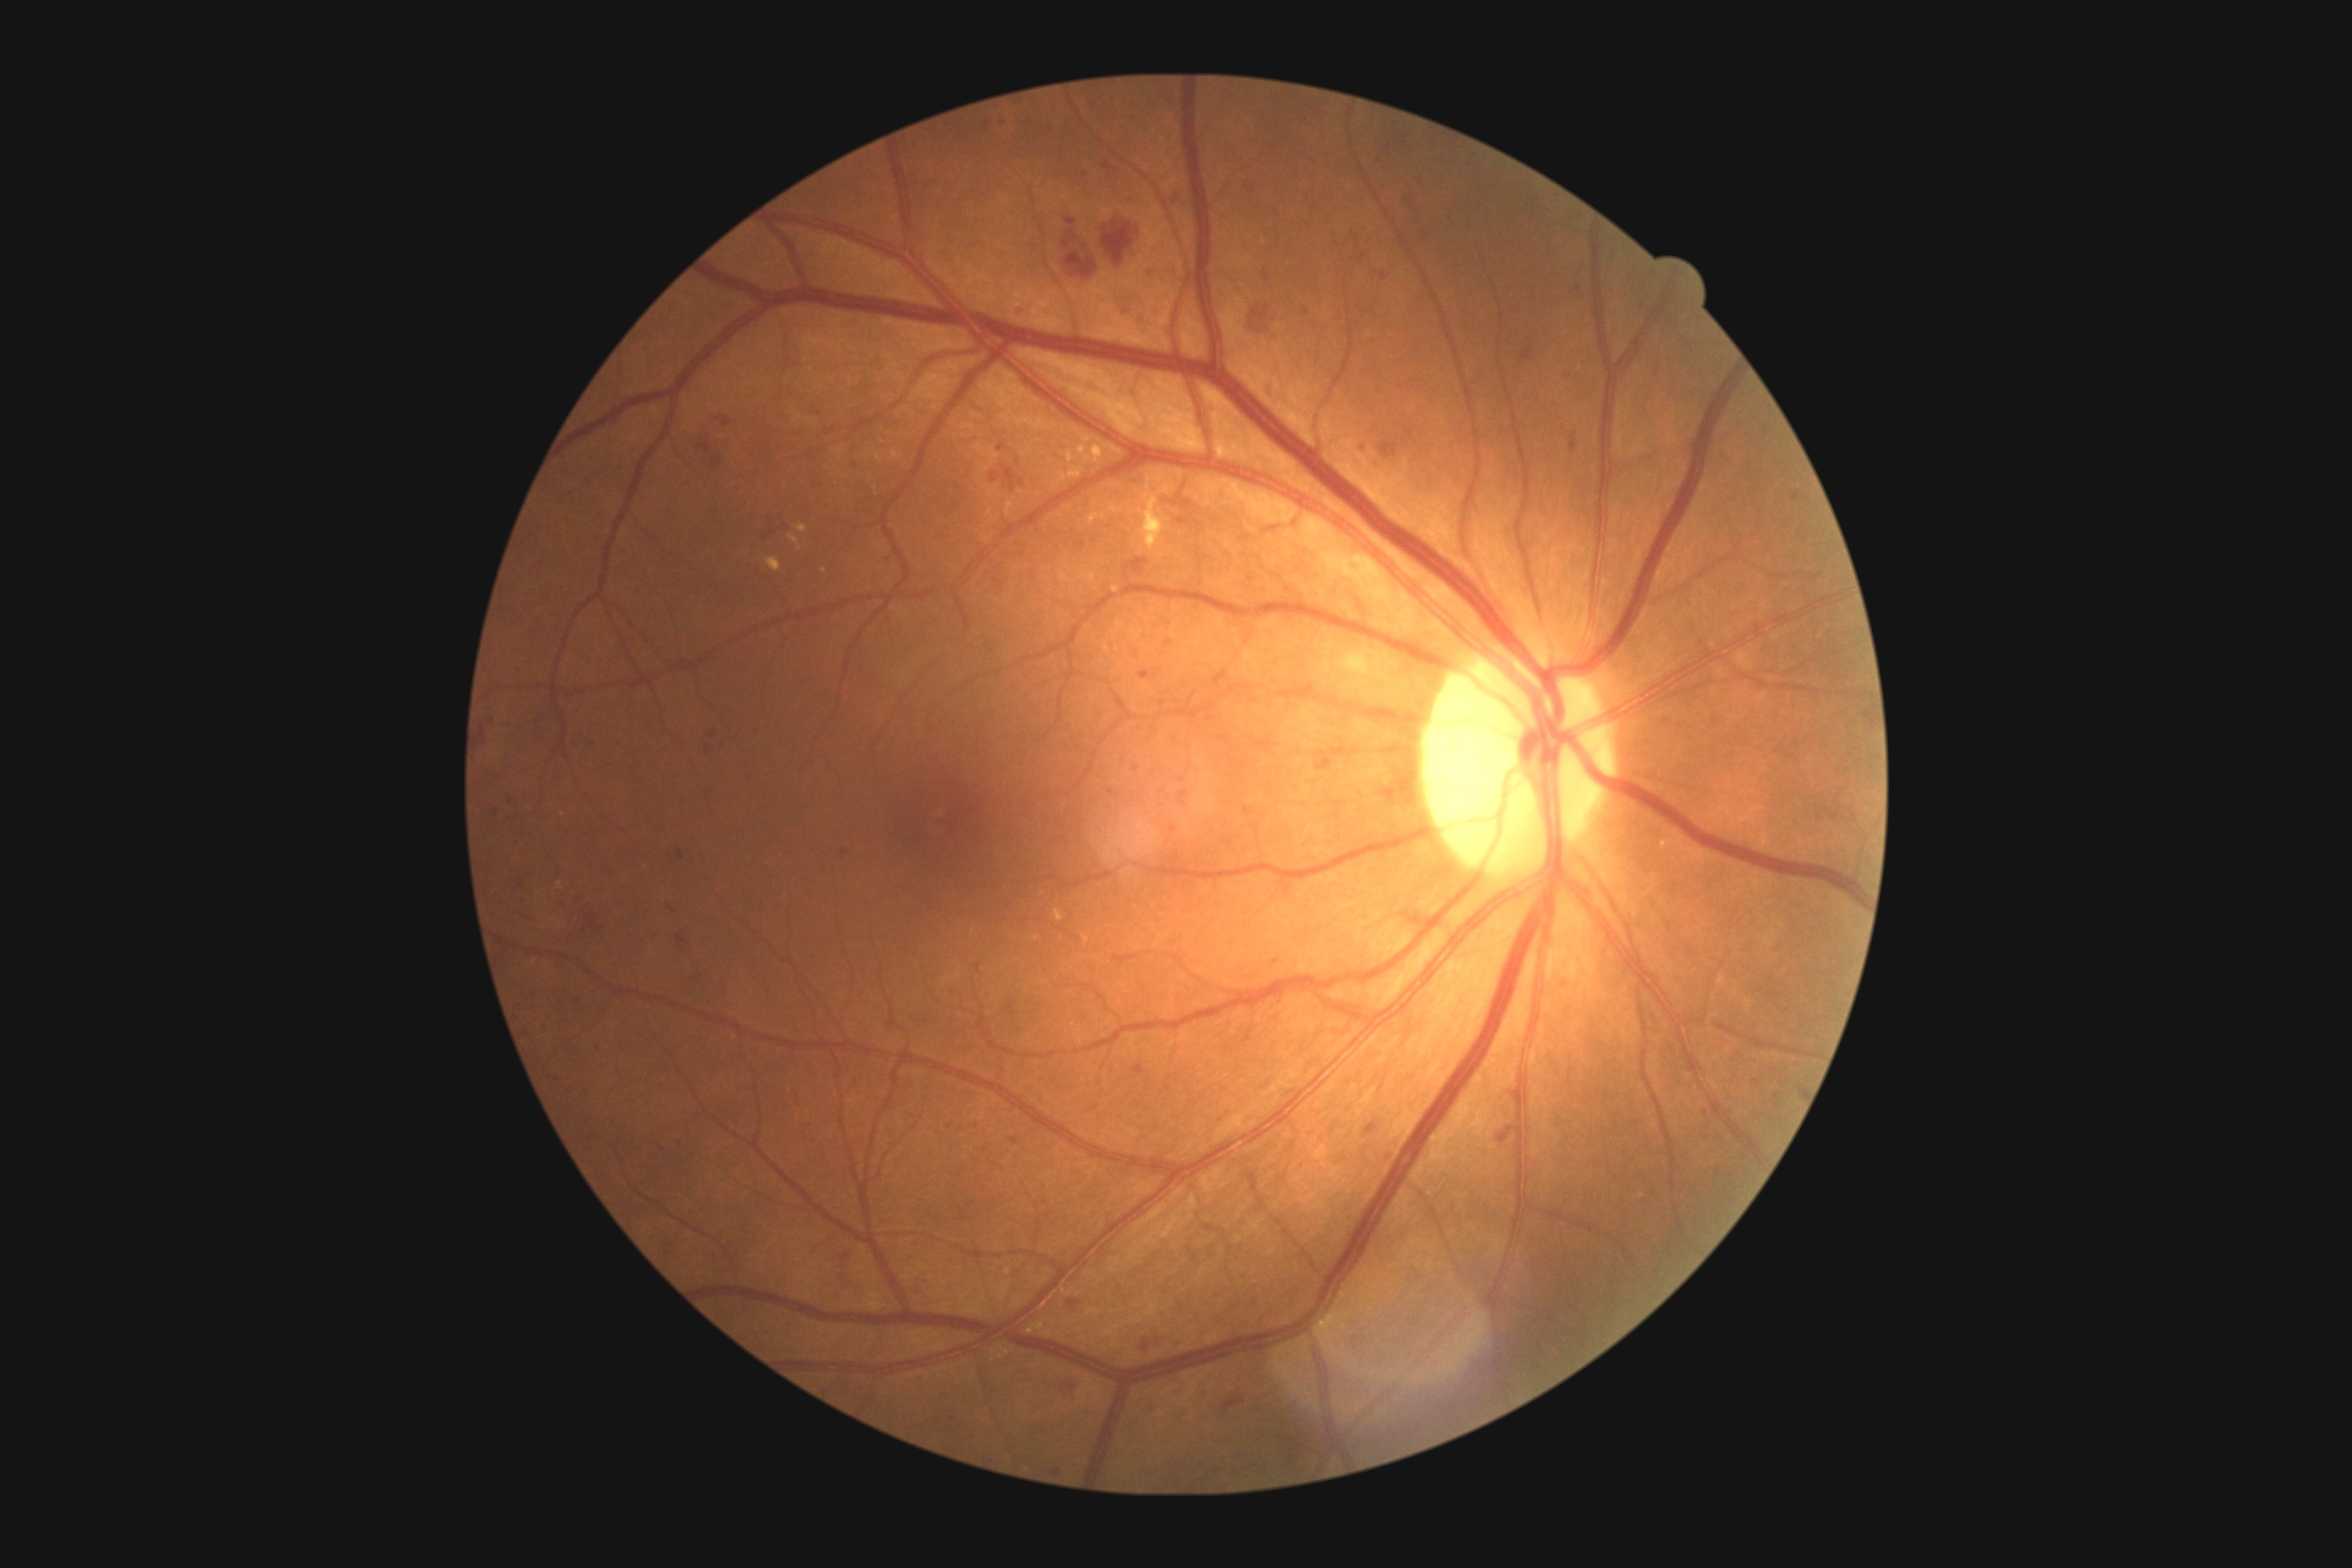 Annotations:
- DR class: non-proliferative diabetic retinopathy
- DR severity: grade 3 (severe NPDR) — more than 20 intraretinal hemorrhages in each of 4 quadrants, definite venous beading in 2 or more quadrants, or prominent intraretinal microvascular abnormalities in 1 or more quadrants, with no signs of proliferative retinopathy